Infant wide-field retinal image: 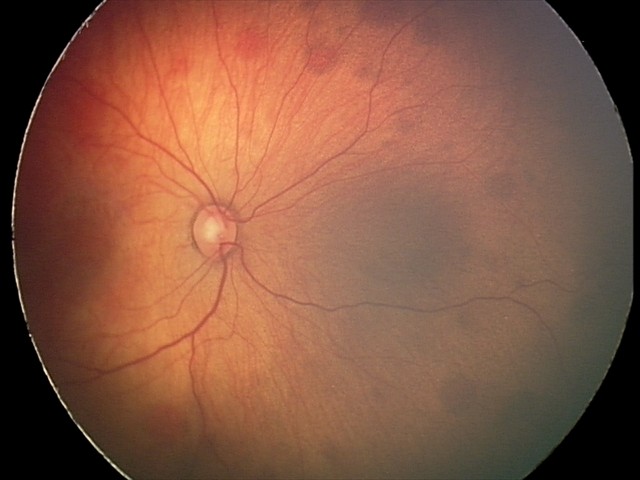

Assessment = retinal hemorrhages